Camera: Phoenix ICON (100° FOV) · wide-field contact fundus photograph of an infant.
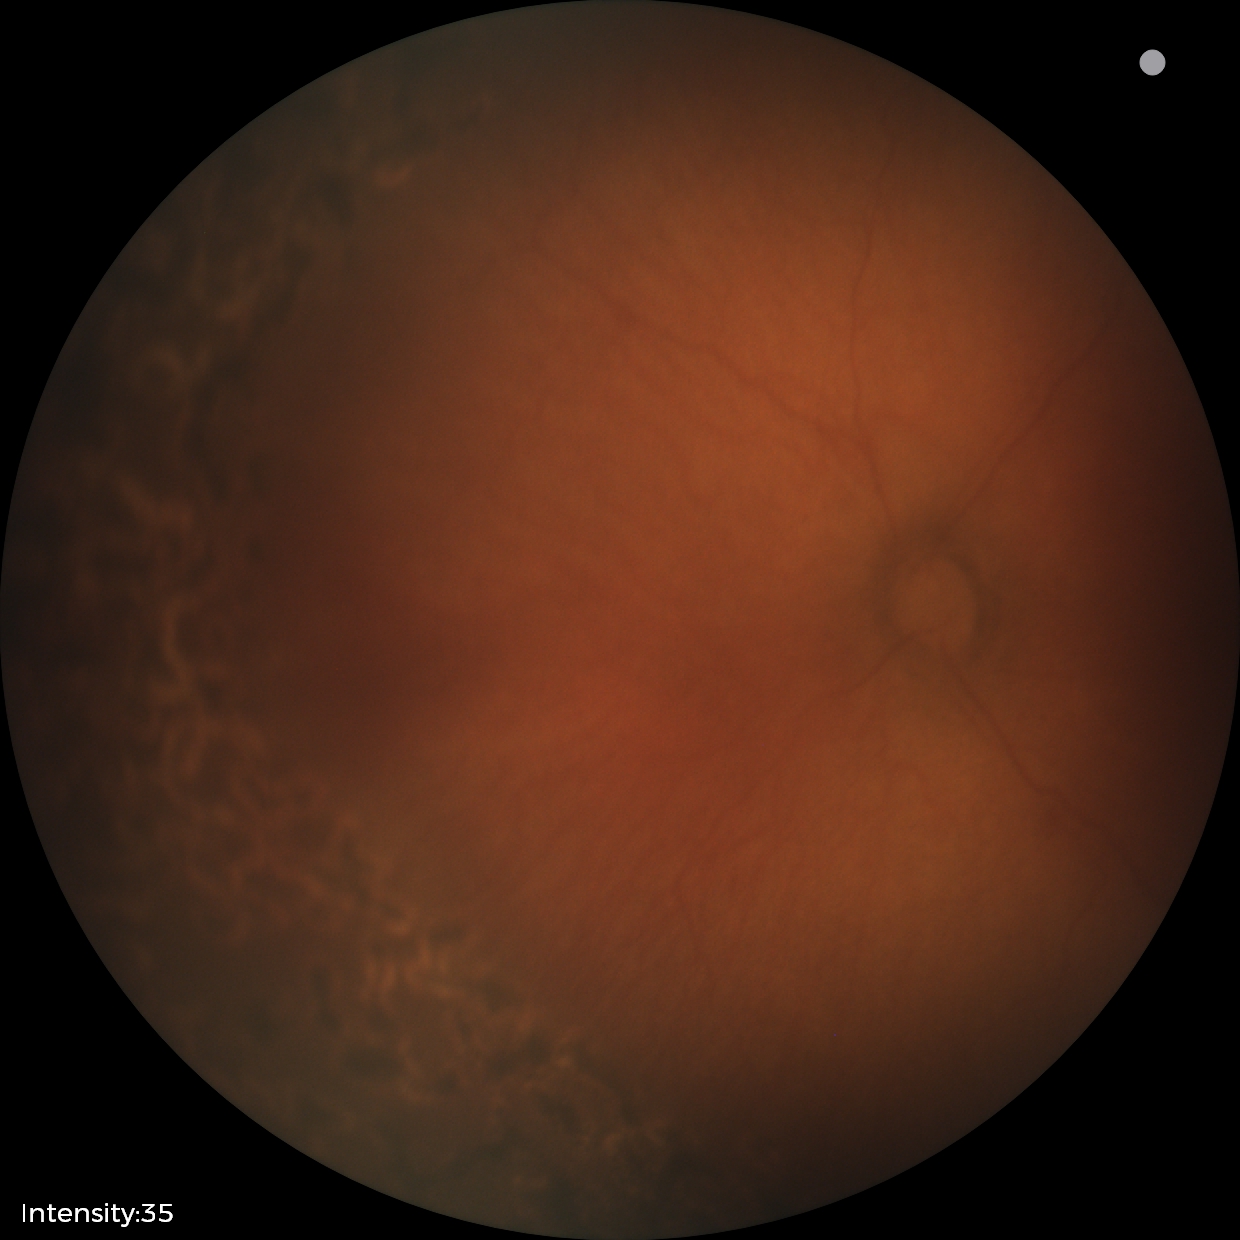 Screening examination consistent with status post ROP.